Wide-field fundus image from infant ROP screening
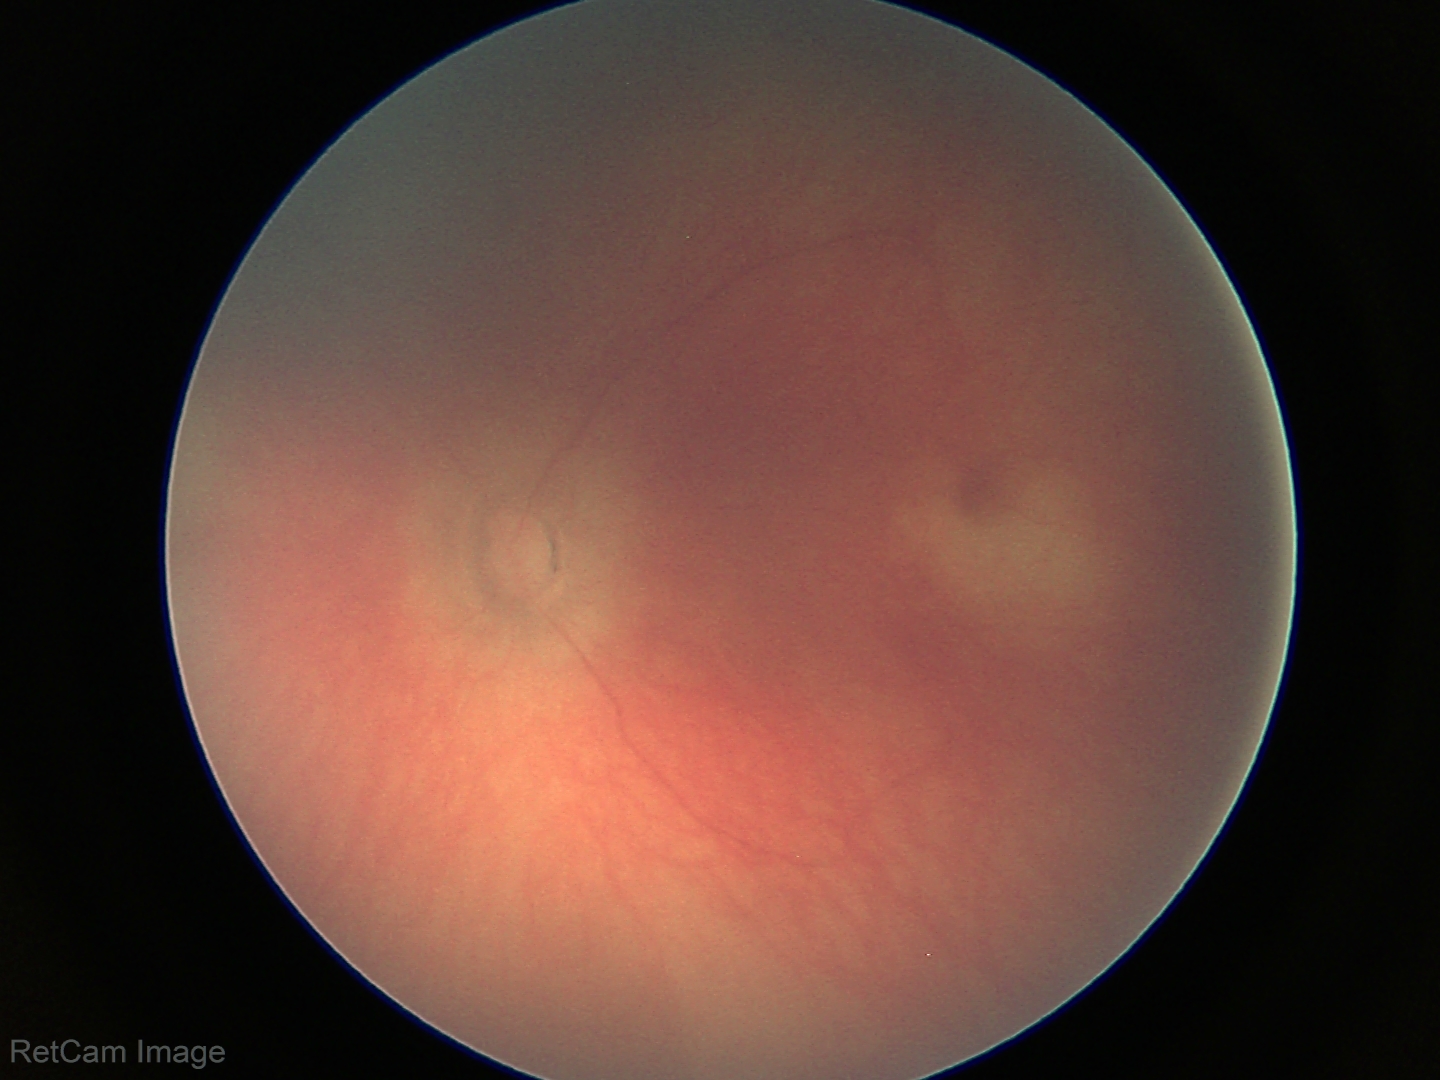
Physiological retinal appearance for postconceptual age.